50° FOV; retinal fundus photograph; 2361 by 1568 pixels
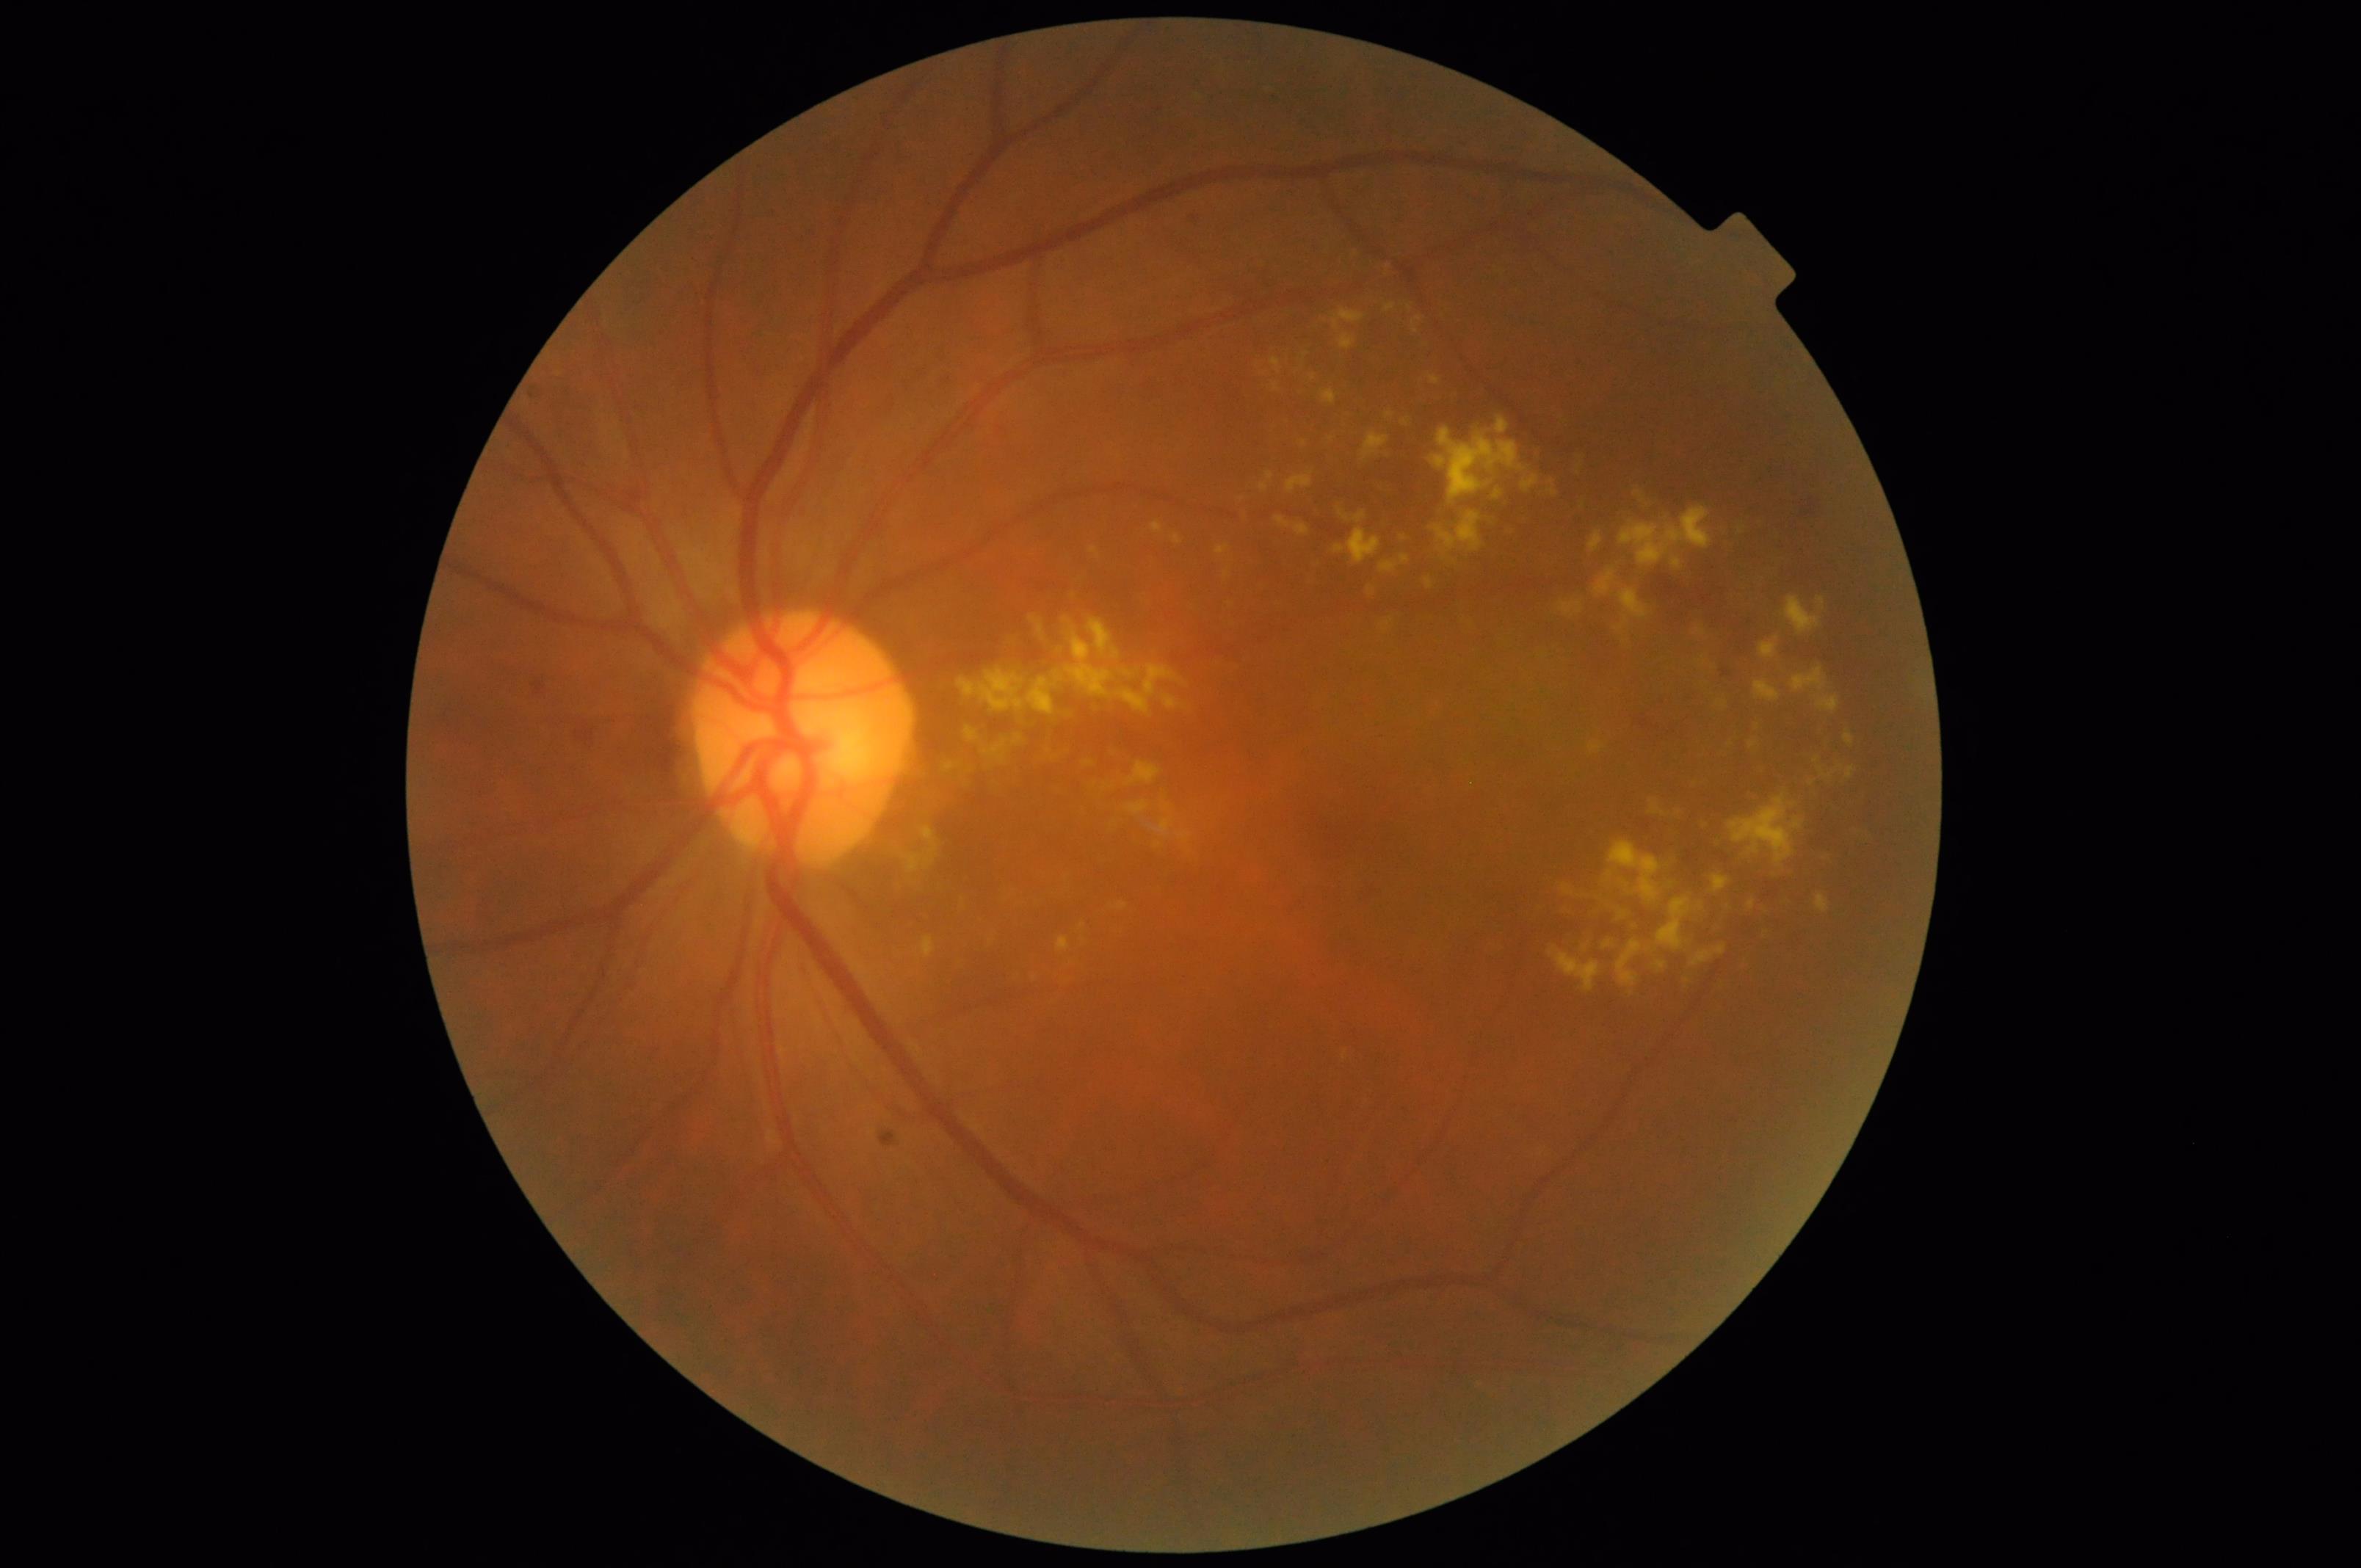

Illumination is even. Optic disc, vessels, and background are in focus. Overall image quality is good.